Wide-field fundus photograph of an infant
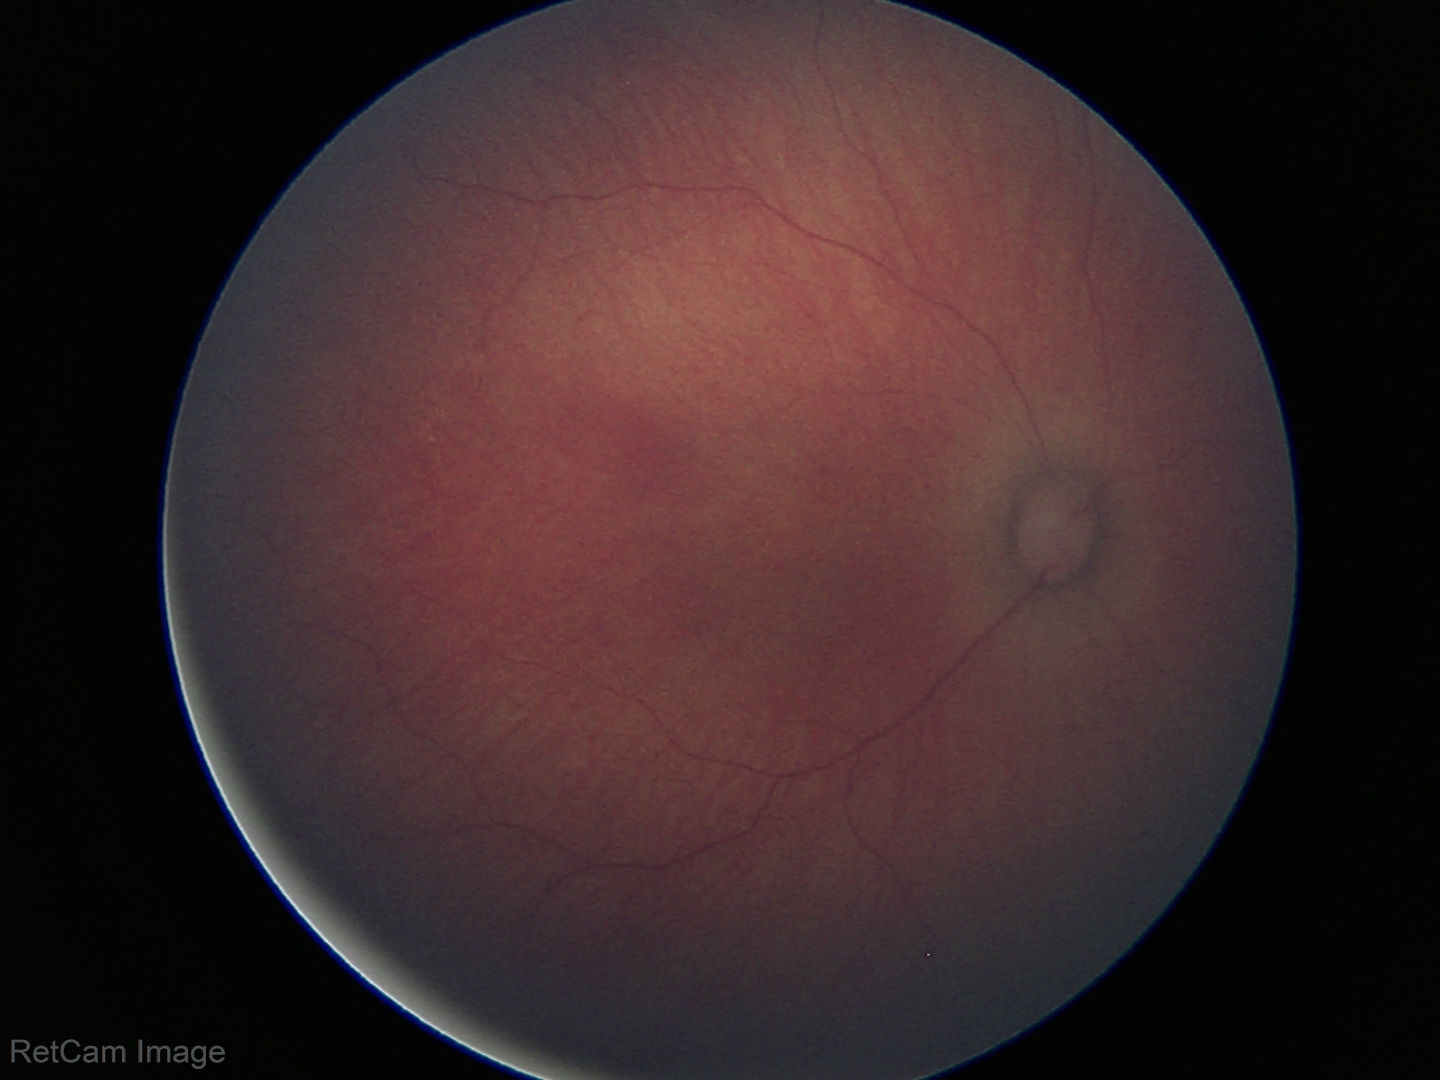

Normal screening examination.